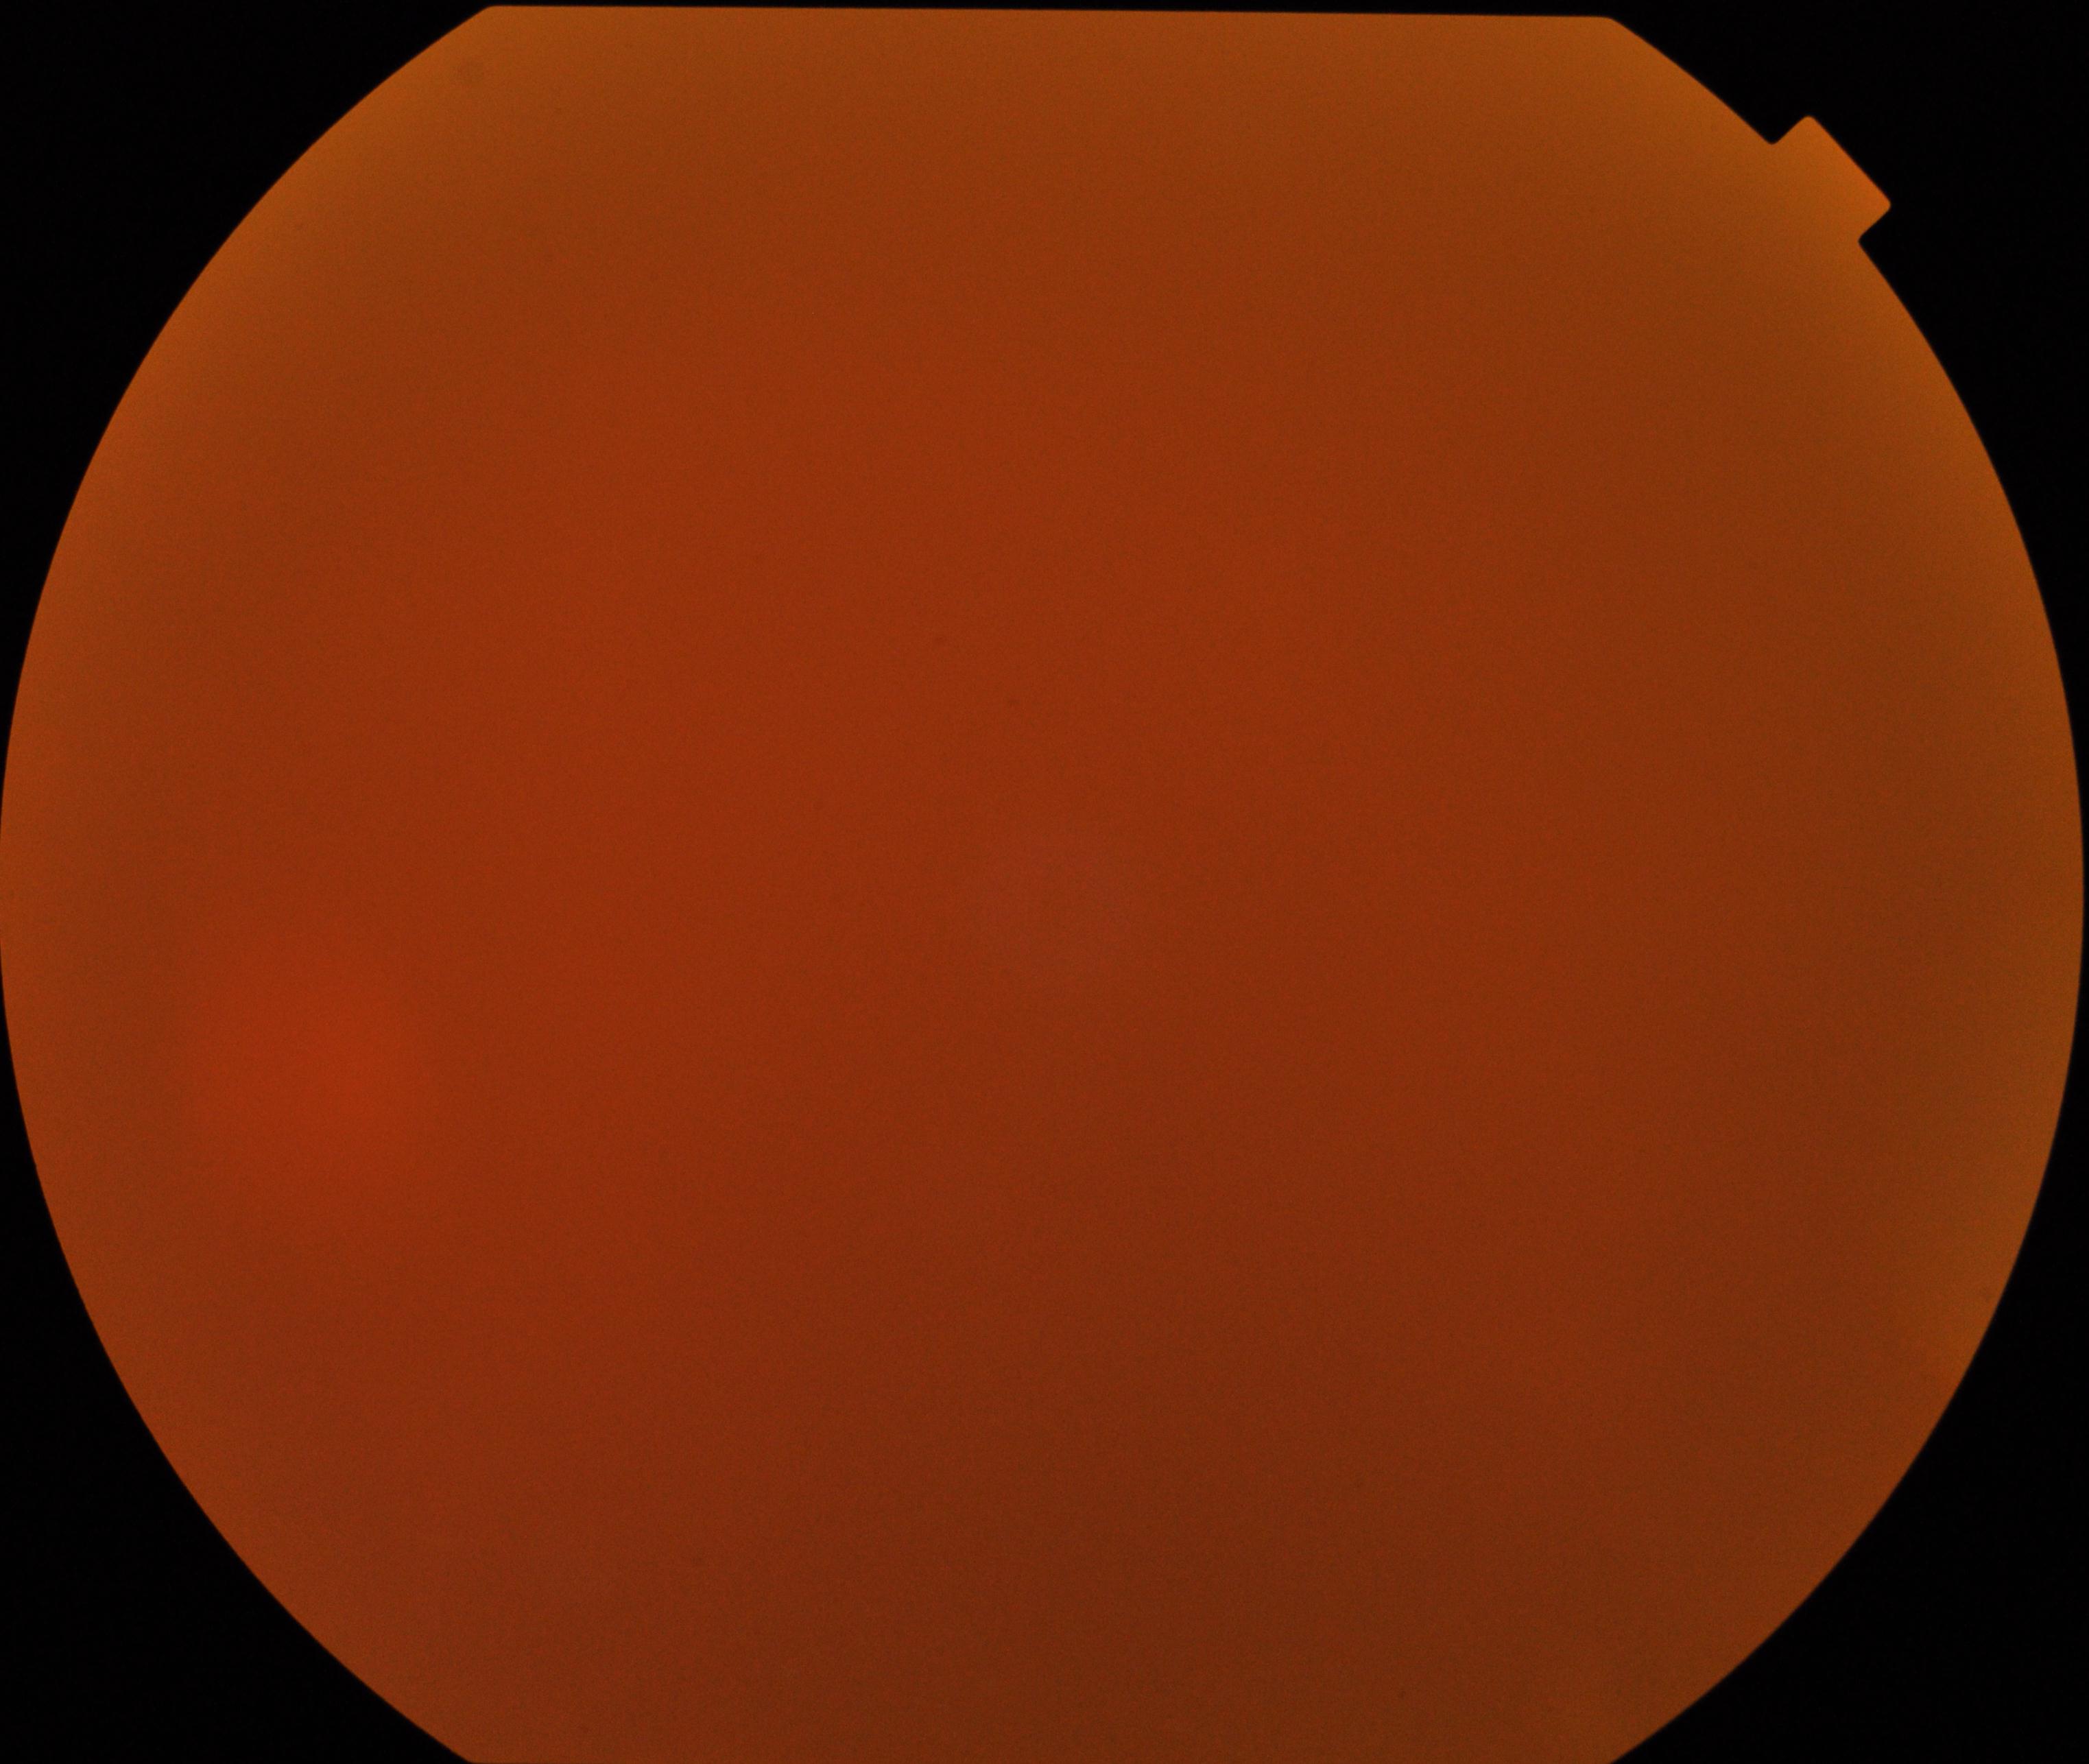
Image quality: poor, substantial obscuration of retinal landmarks. Proliferative retinopathy: negative.